Infant wide-field retinal image:
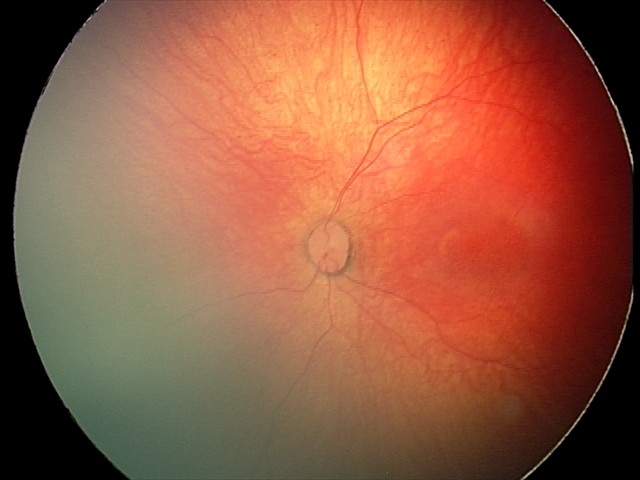 Q: What is the diagnosis from this examination?
A: physiological retinal finding